Fundus photo; 45° field of view.
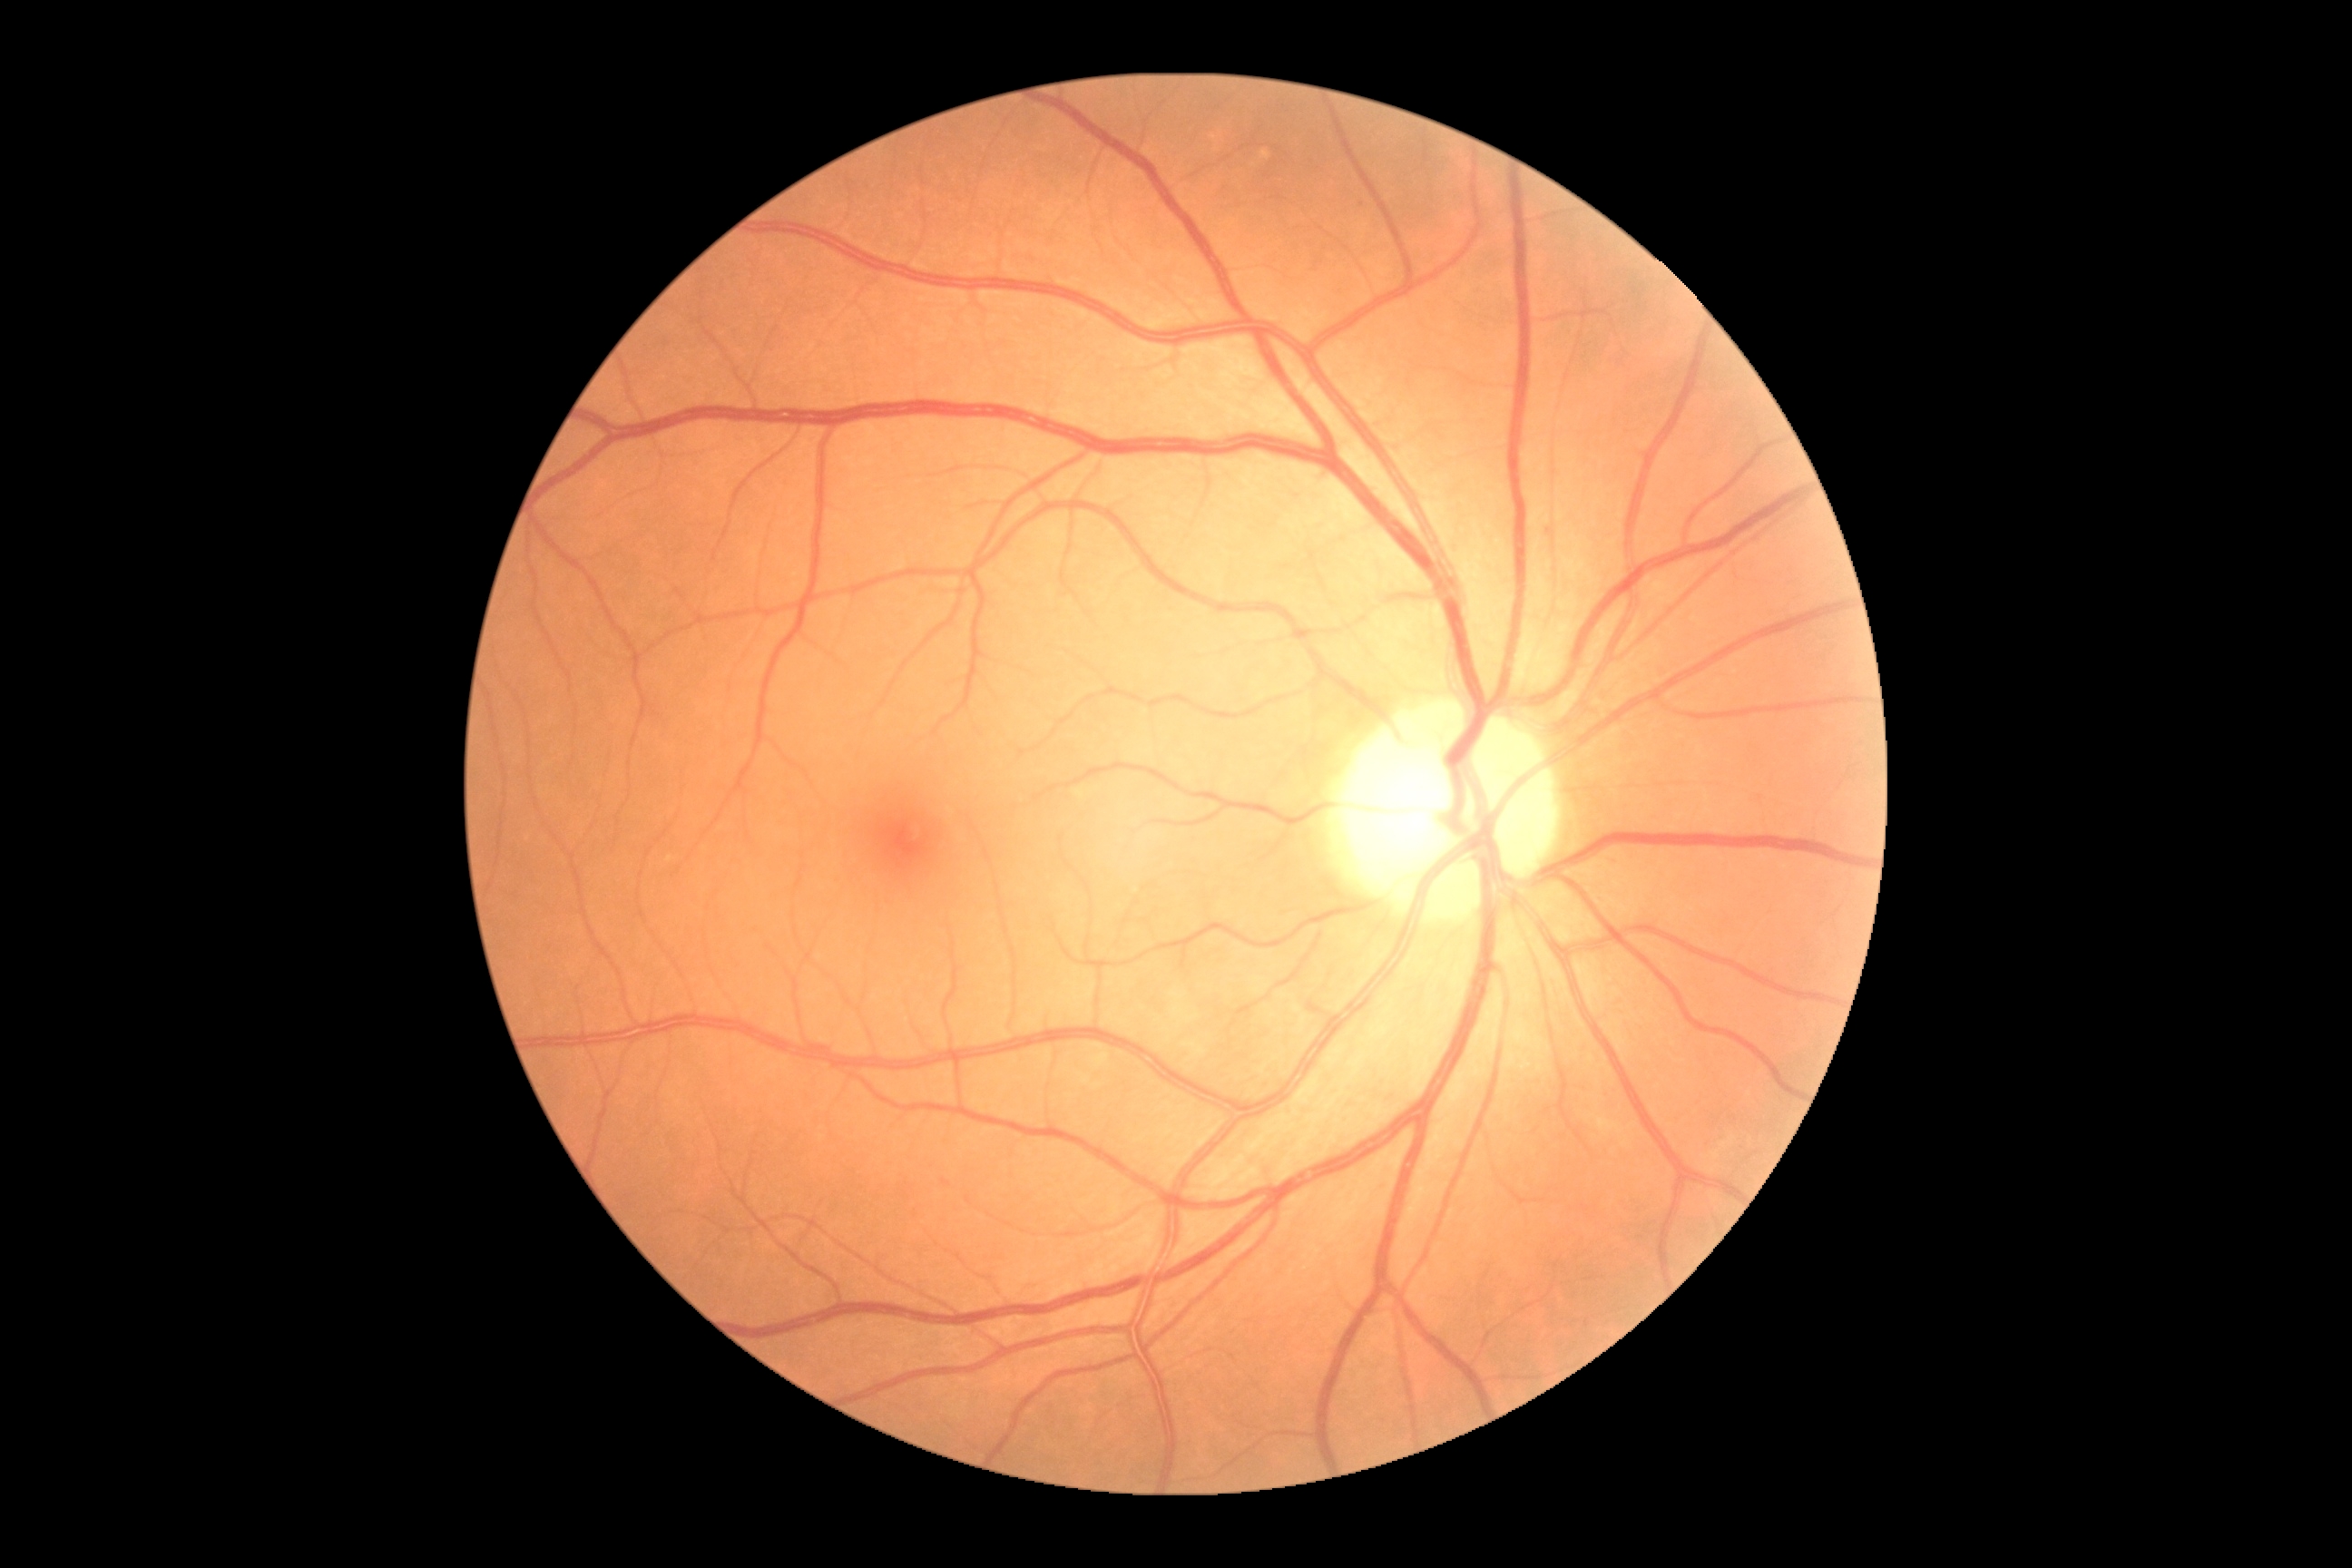

Diabetic retinopathy: grade 0 (no apparent retinopathy).